Wide-field contact fundus photograph of an infant.
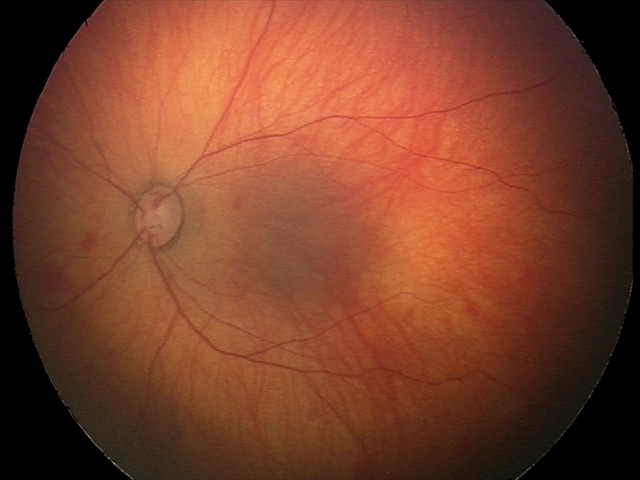 Examination diagnosed as retinal hemorrhages.